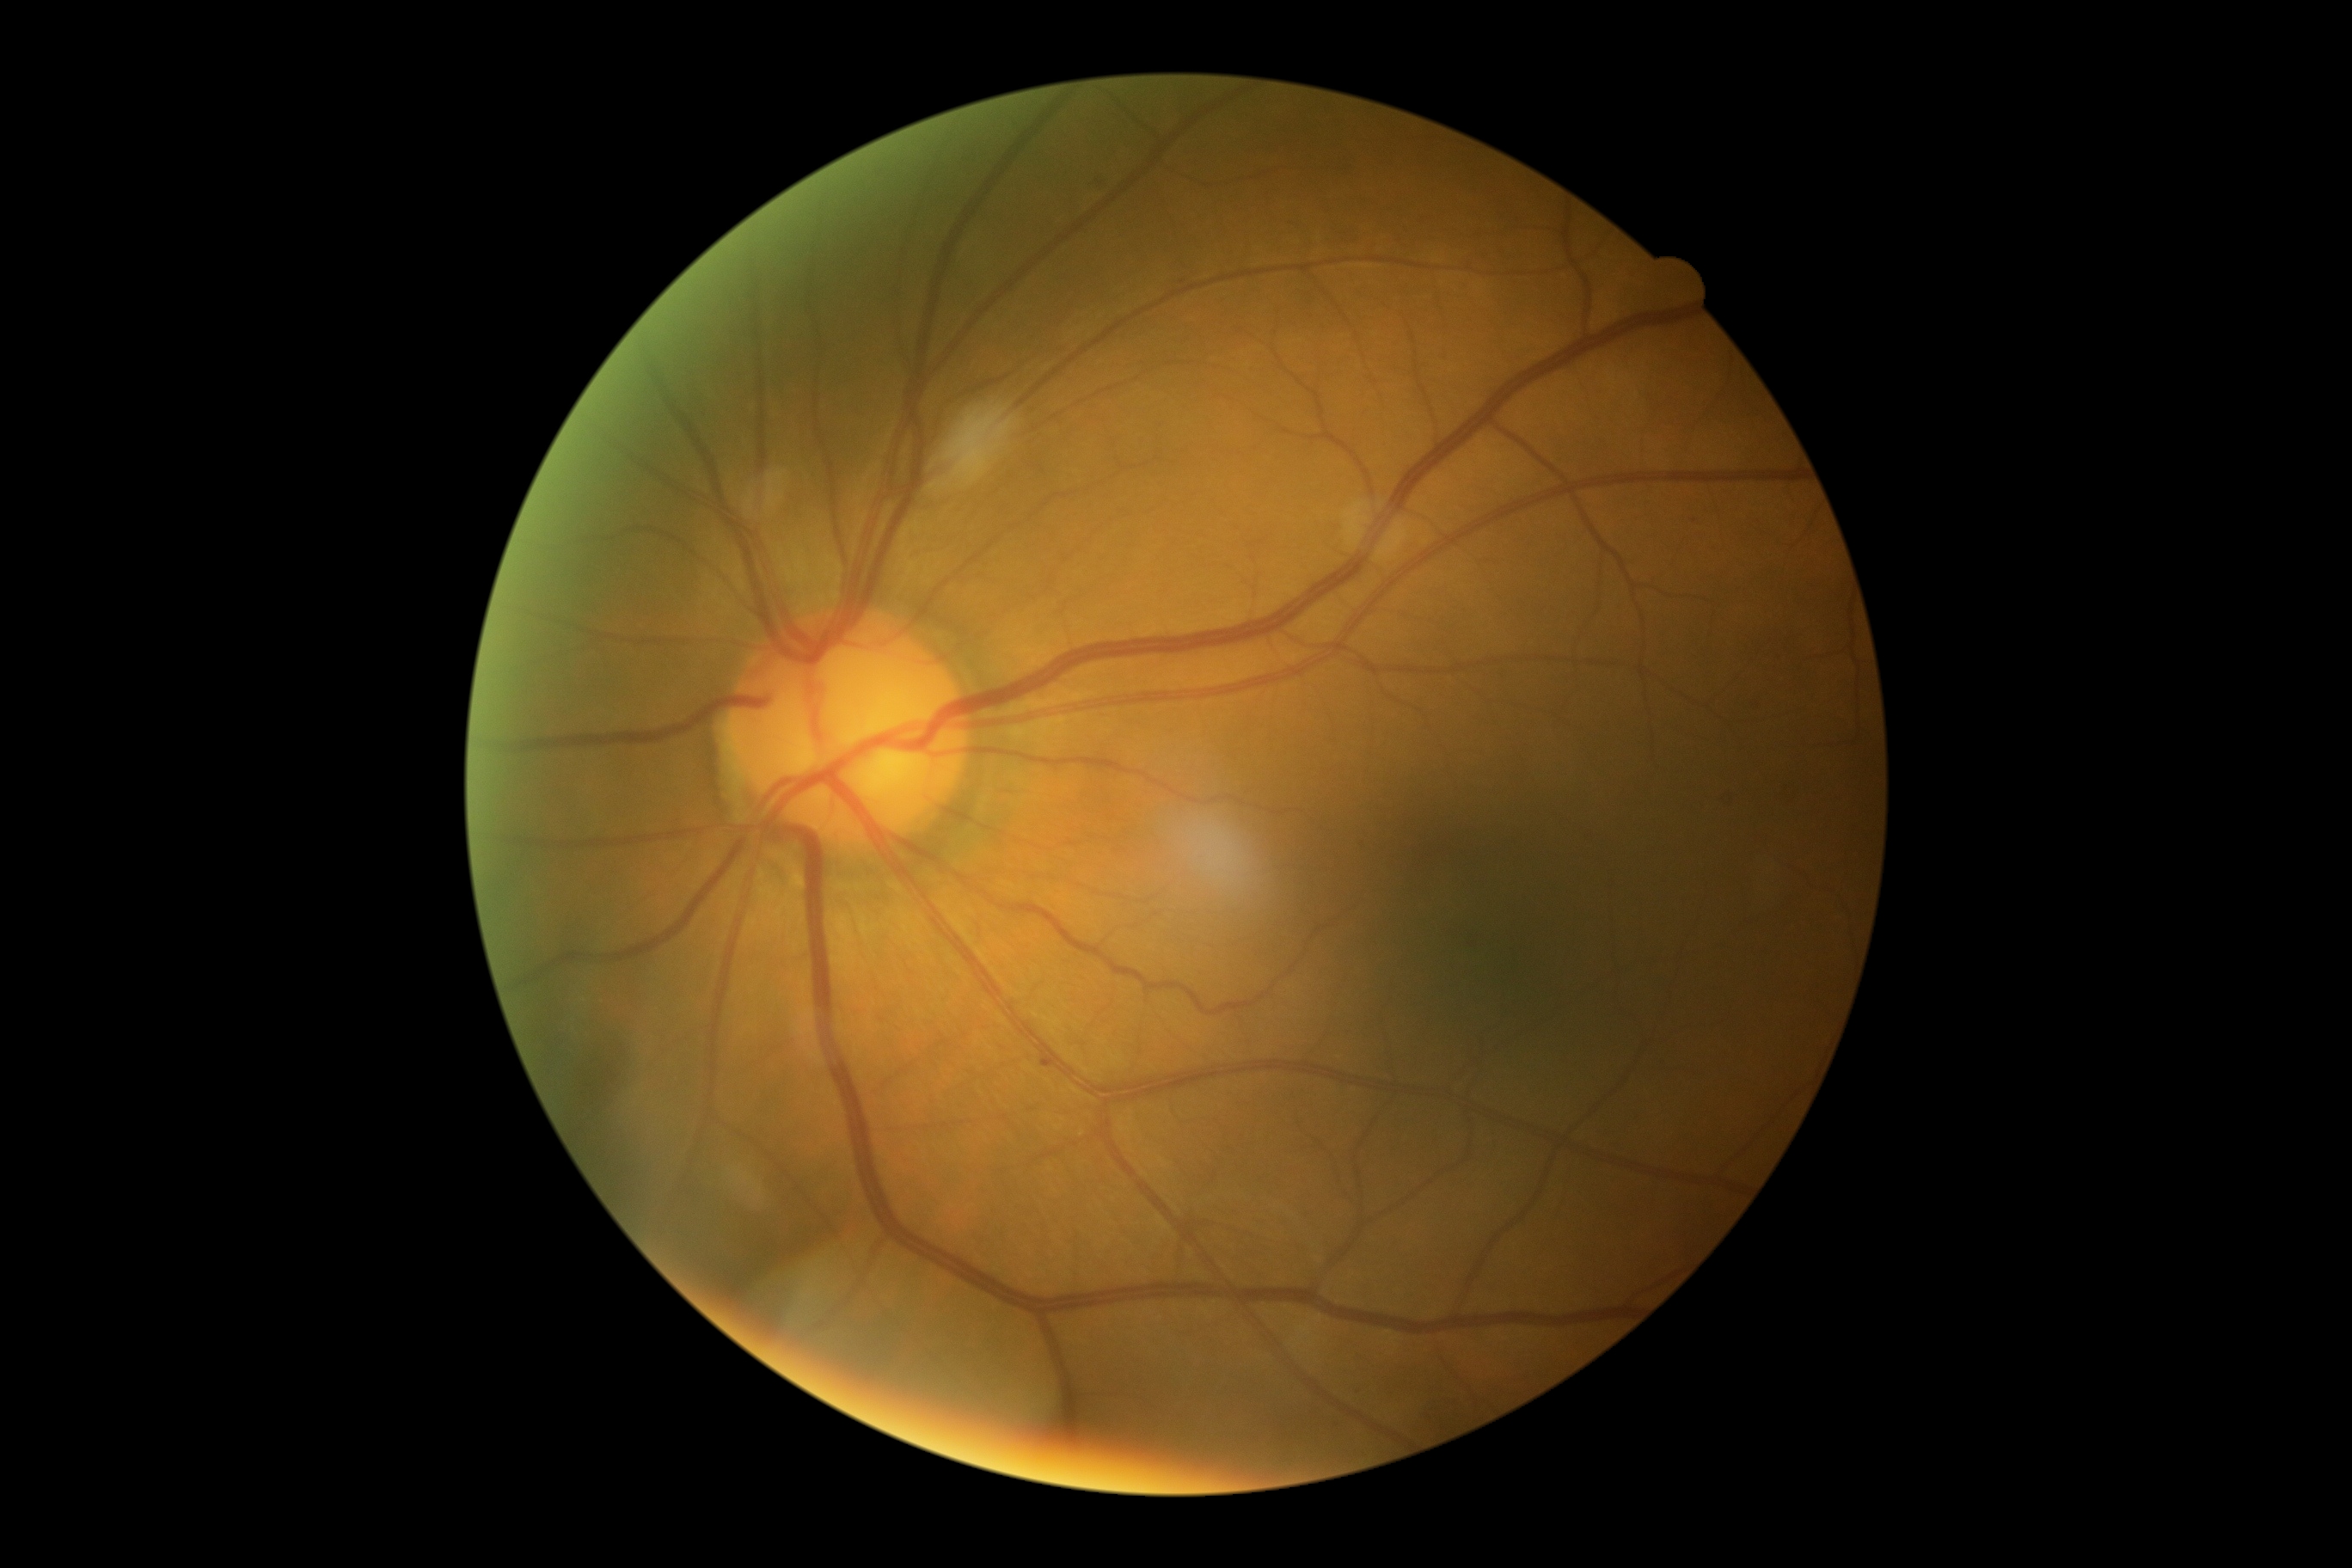
Diabetic retinopathy (DR) is grade 1 (mild NPDR).